Pediatric wide-field fundus photograph · captured with the Clarity RetCam 3 (130° field of view) — 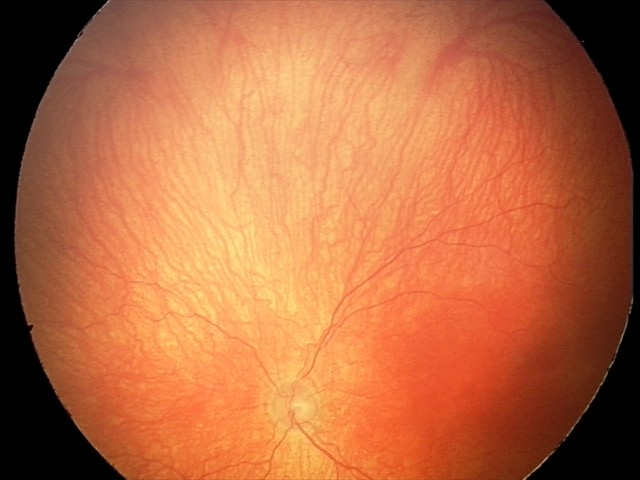

Examination diagnosed as aggressive retinopathy of prematurity. Plus disease present.